Mydriatic. Topcon TRC retinal camera, IMAGEnet capture system. Optic disc region of a color fundus photo: 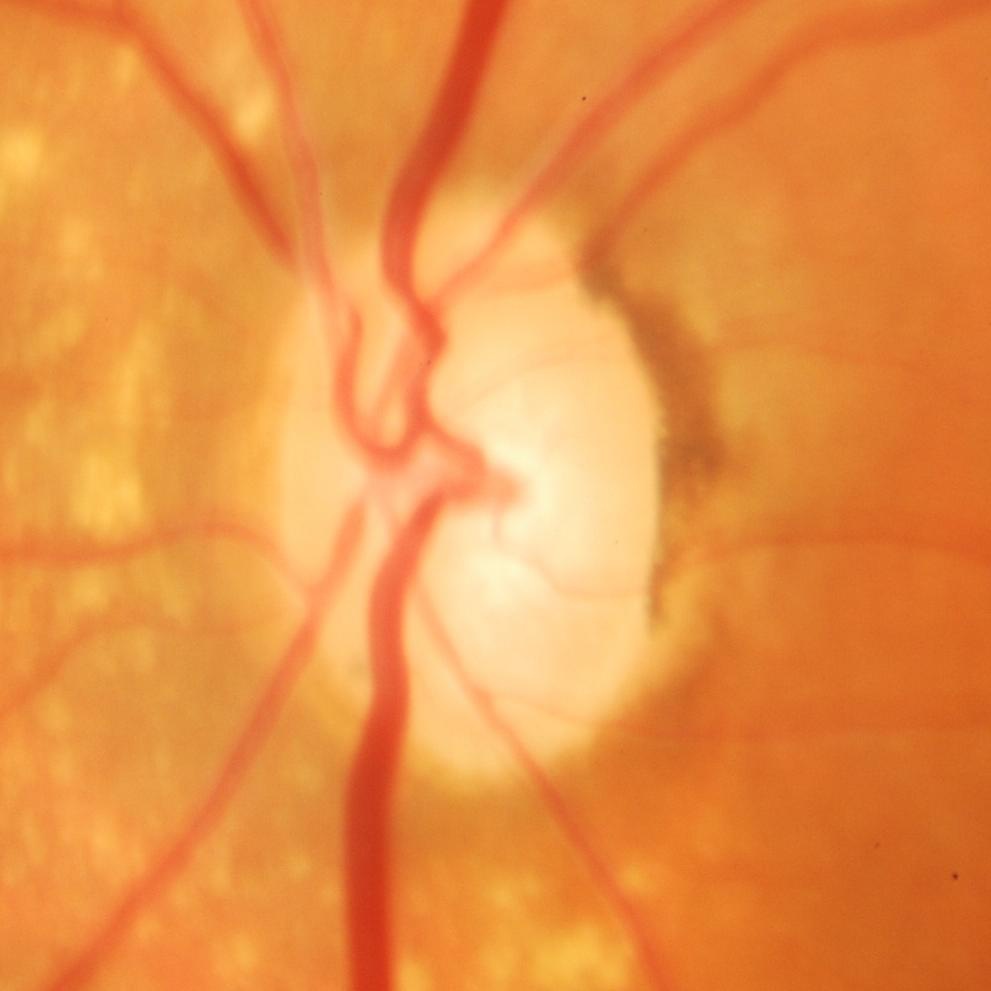
Glaucoma is present. Showing glaucomatous changes.